Pediatric retinal photograph (wide-field). Captured with the Clarity RetCam 3 (130° field of view). 640x480: 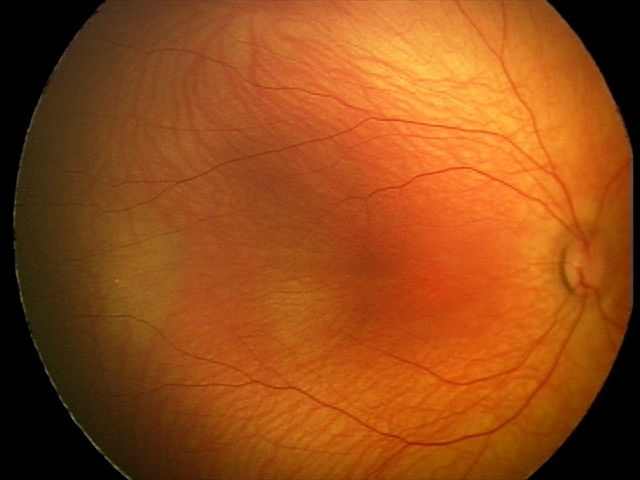

Examination with physiological retinal findings.